RetCam wide-field infant fundus image · captured with the Natus RetCam Envision (130° field of view)
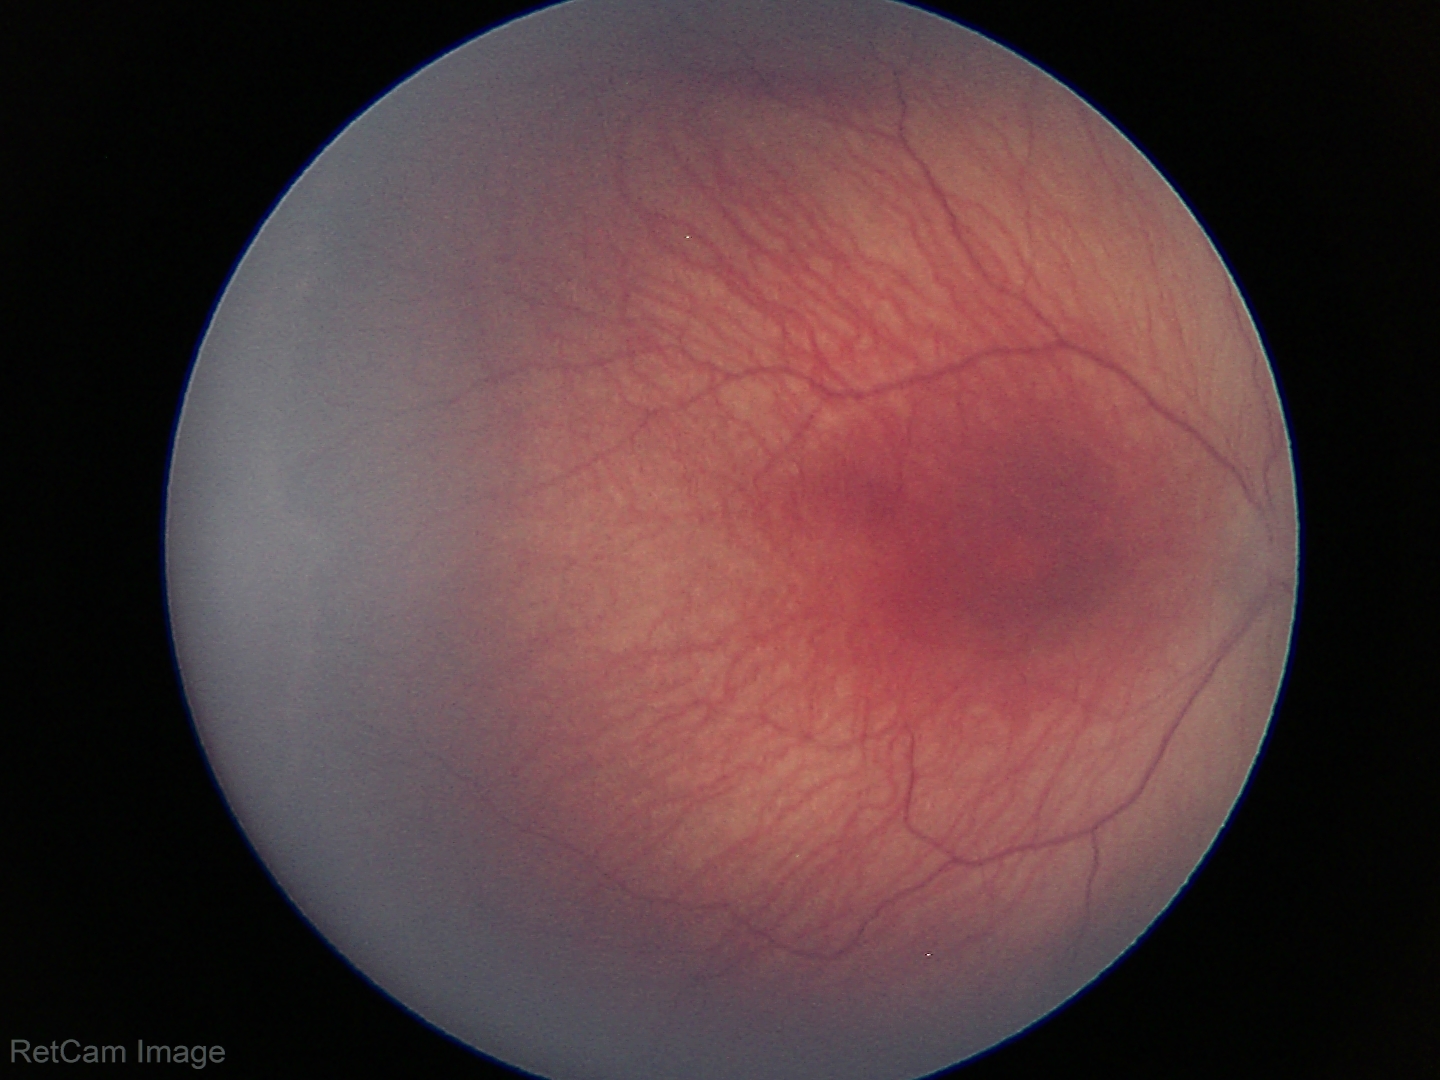

Without plus disease. From an examination with diagnosis of retinopathy of prematurity stage 1.